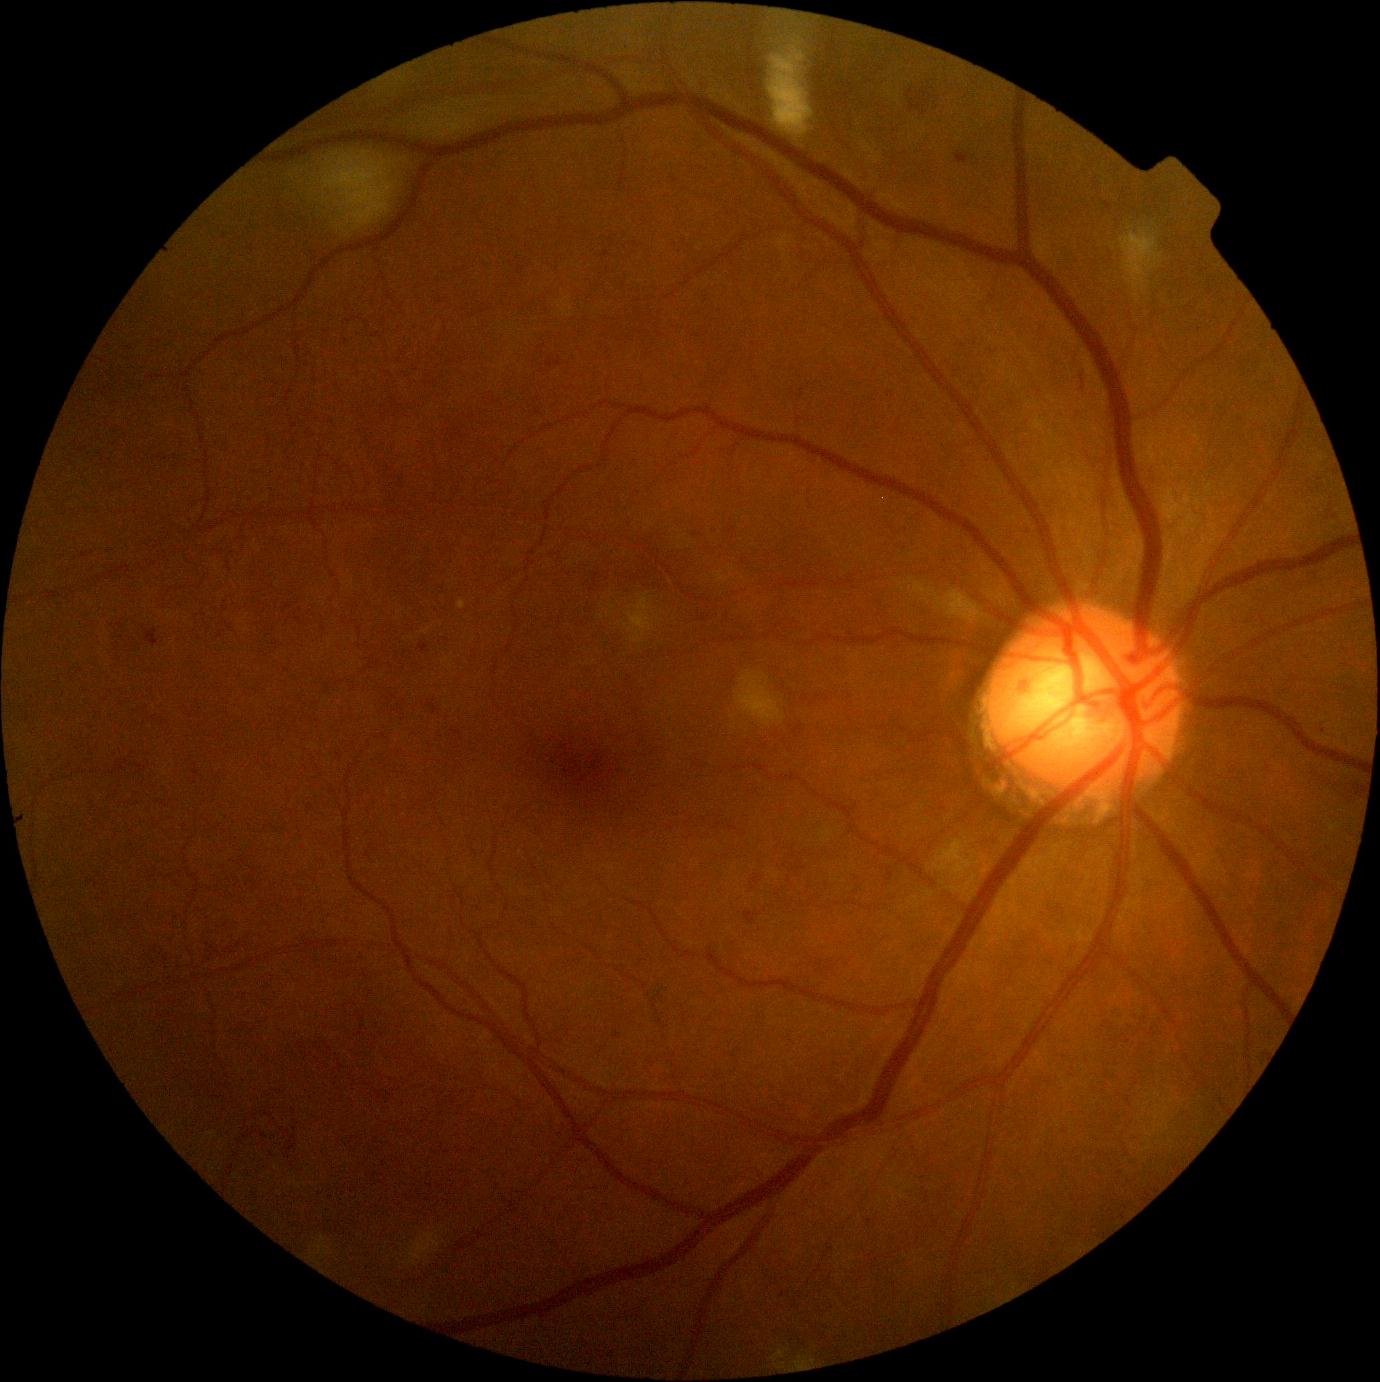

Diabetic retinopathy (DR) is grade 2 (moderate NPDR).